Nonmydriatic fundus photograph · color fundus photograph · acquired with a NIDEK AFC-230 · DR severity per modified Davis staging.
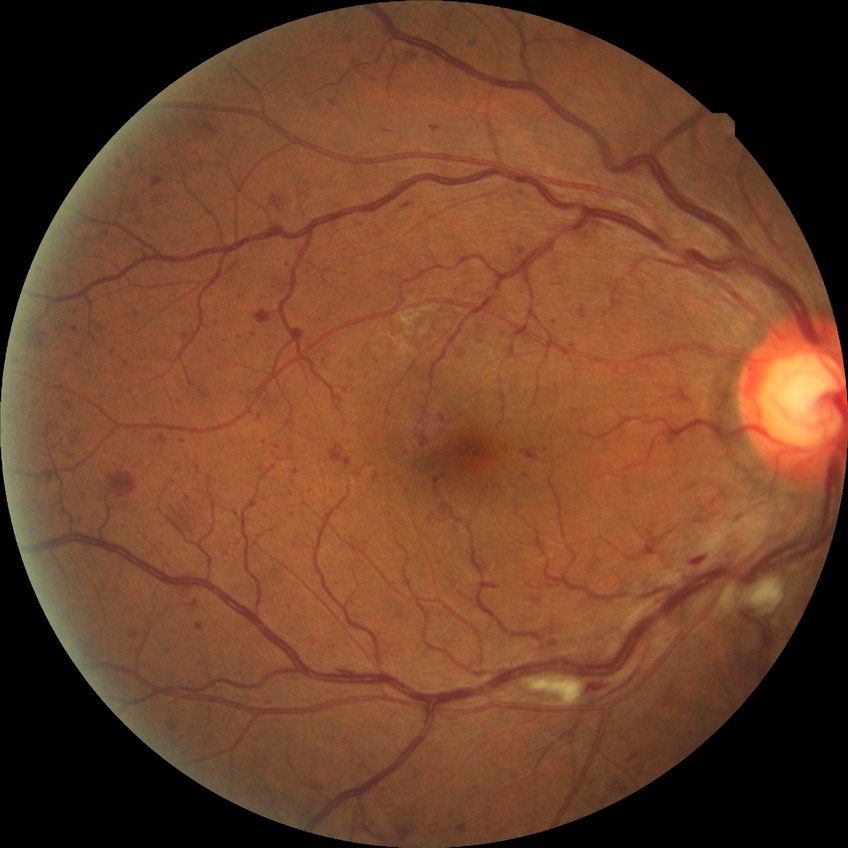 Diabetic retinopathy (DR): simple diabetic retinopathy (SDR).